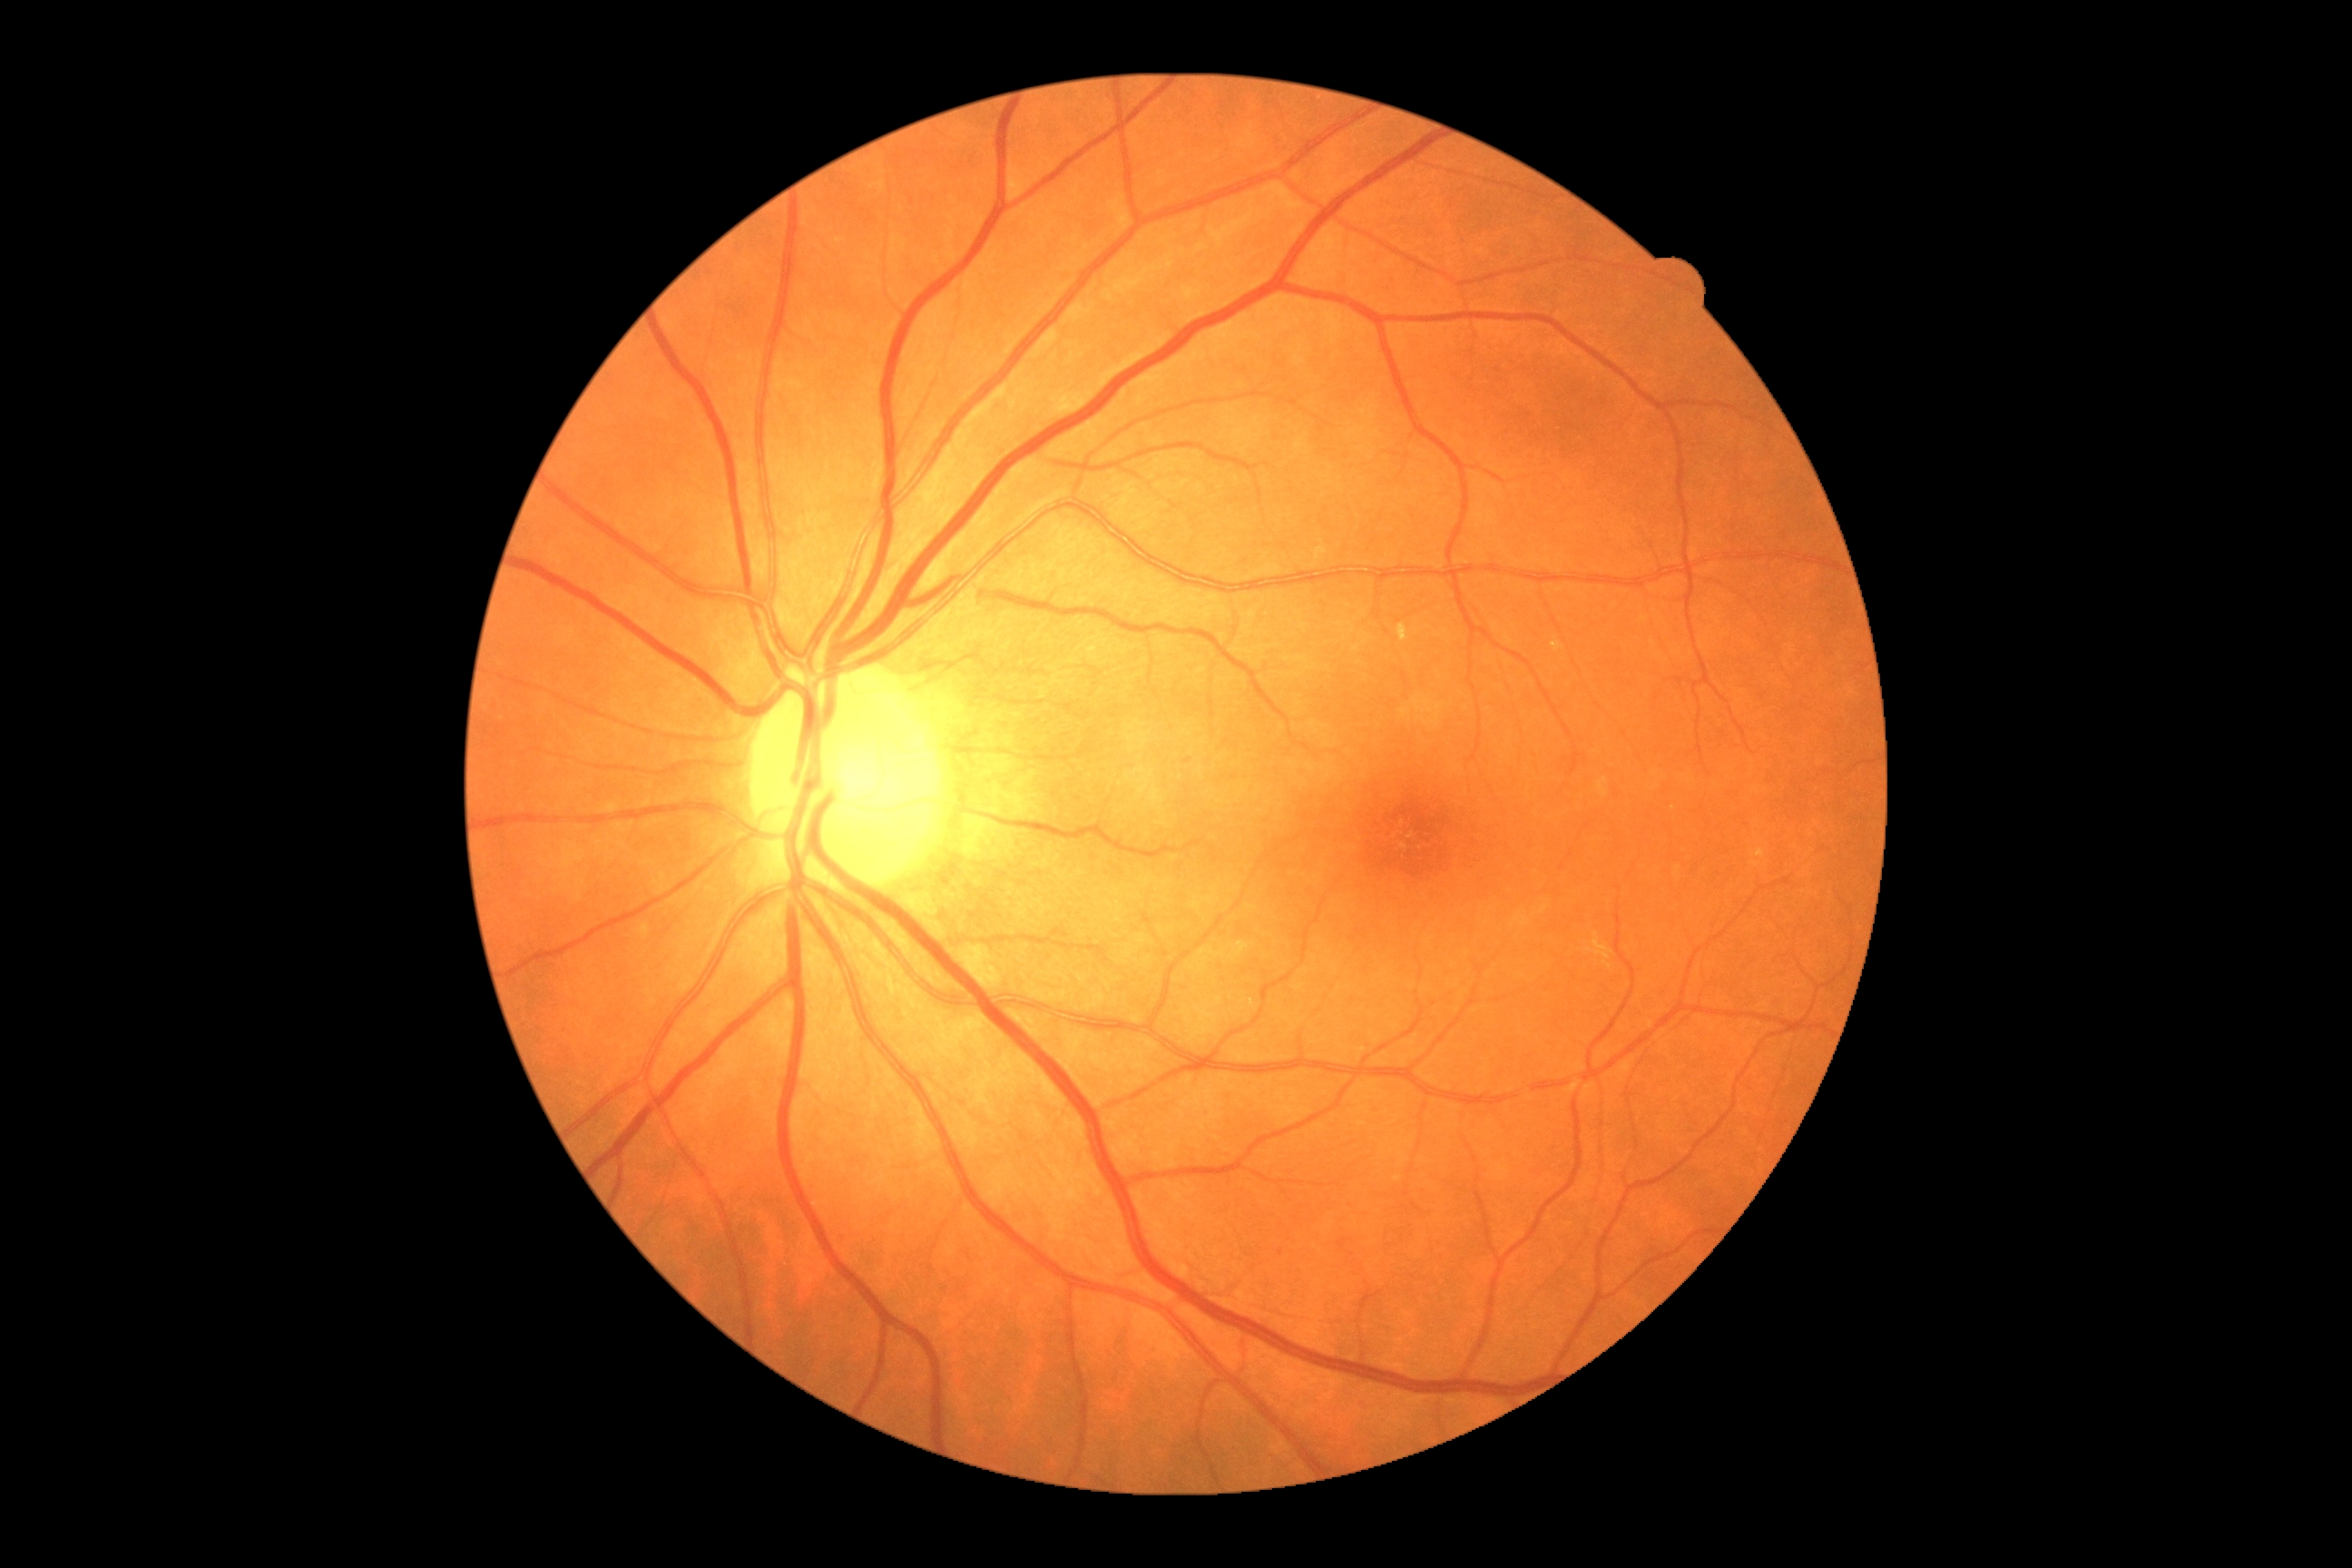 {
  "dr_grade": "no apparent diabetic retinopathy (0)",
  "dr_impression": "no signs of DR"
}